FOV: 45 degrees. Color fundus image. 2212 by 1659 pixels:
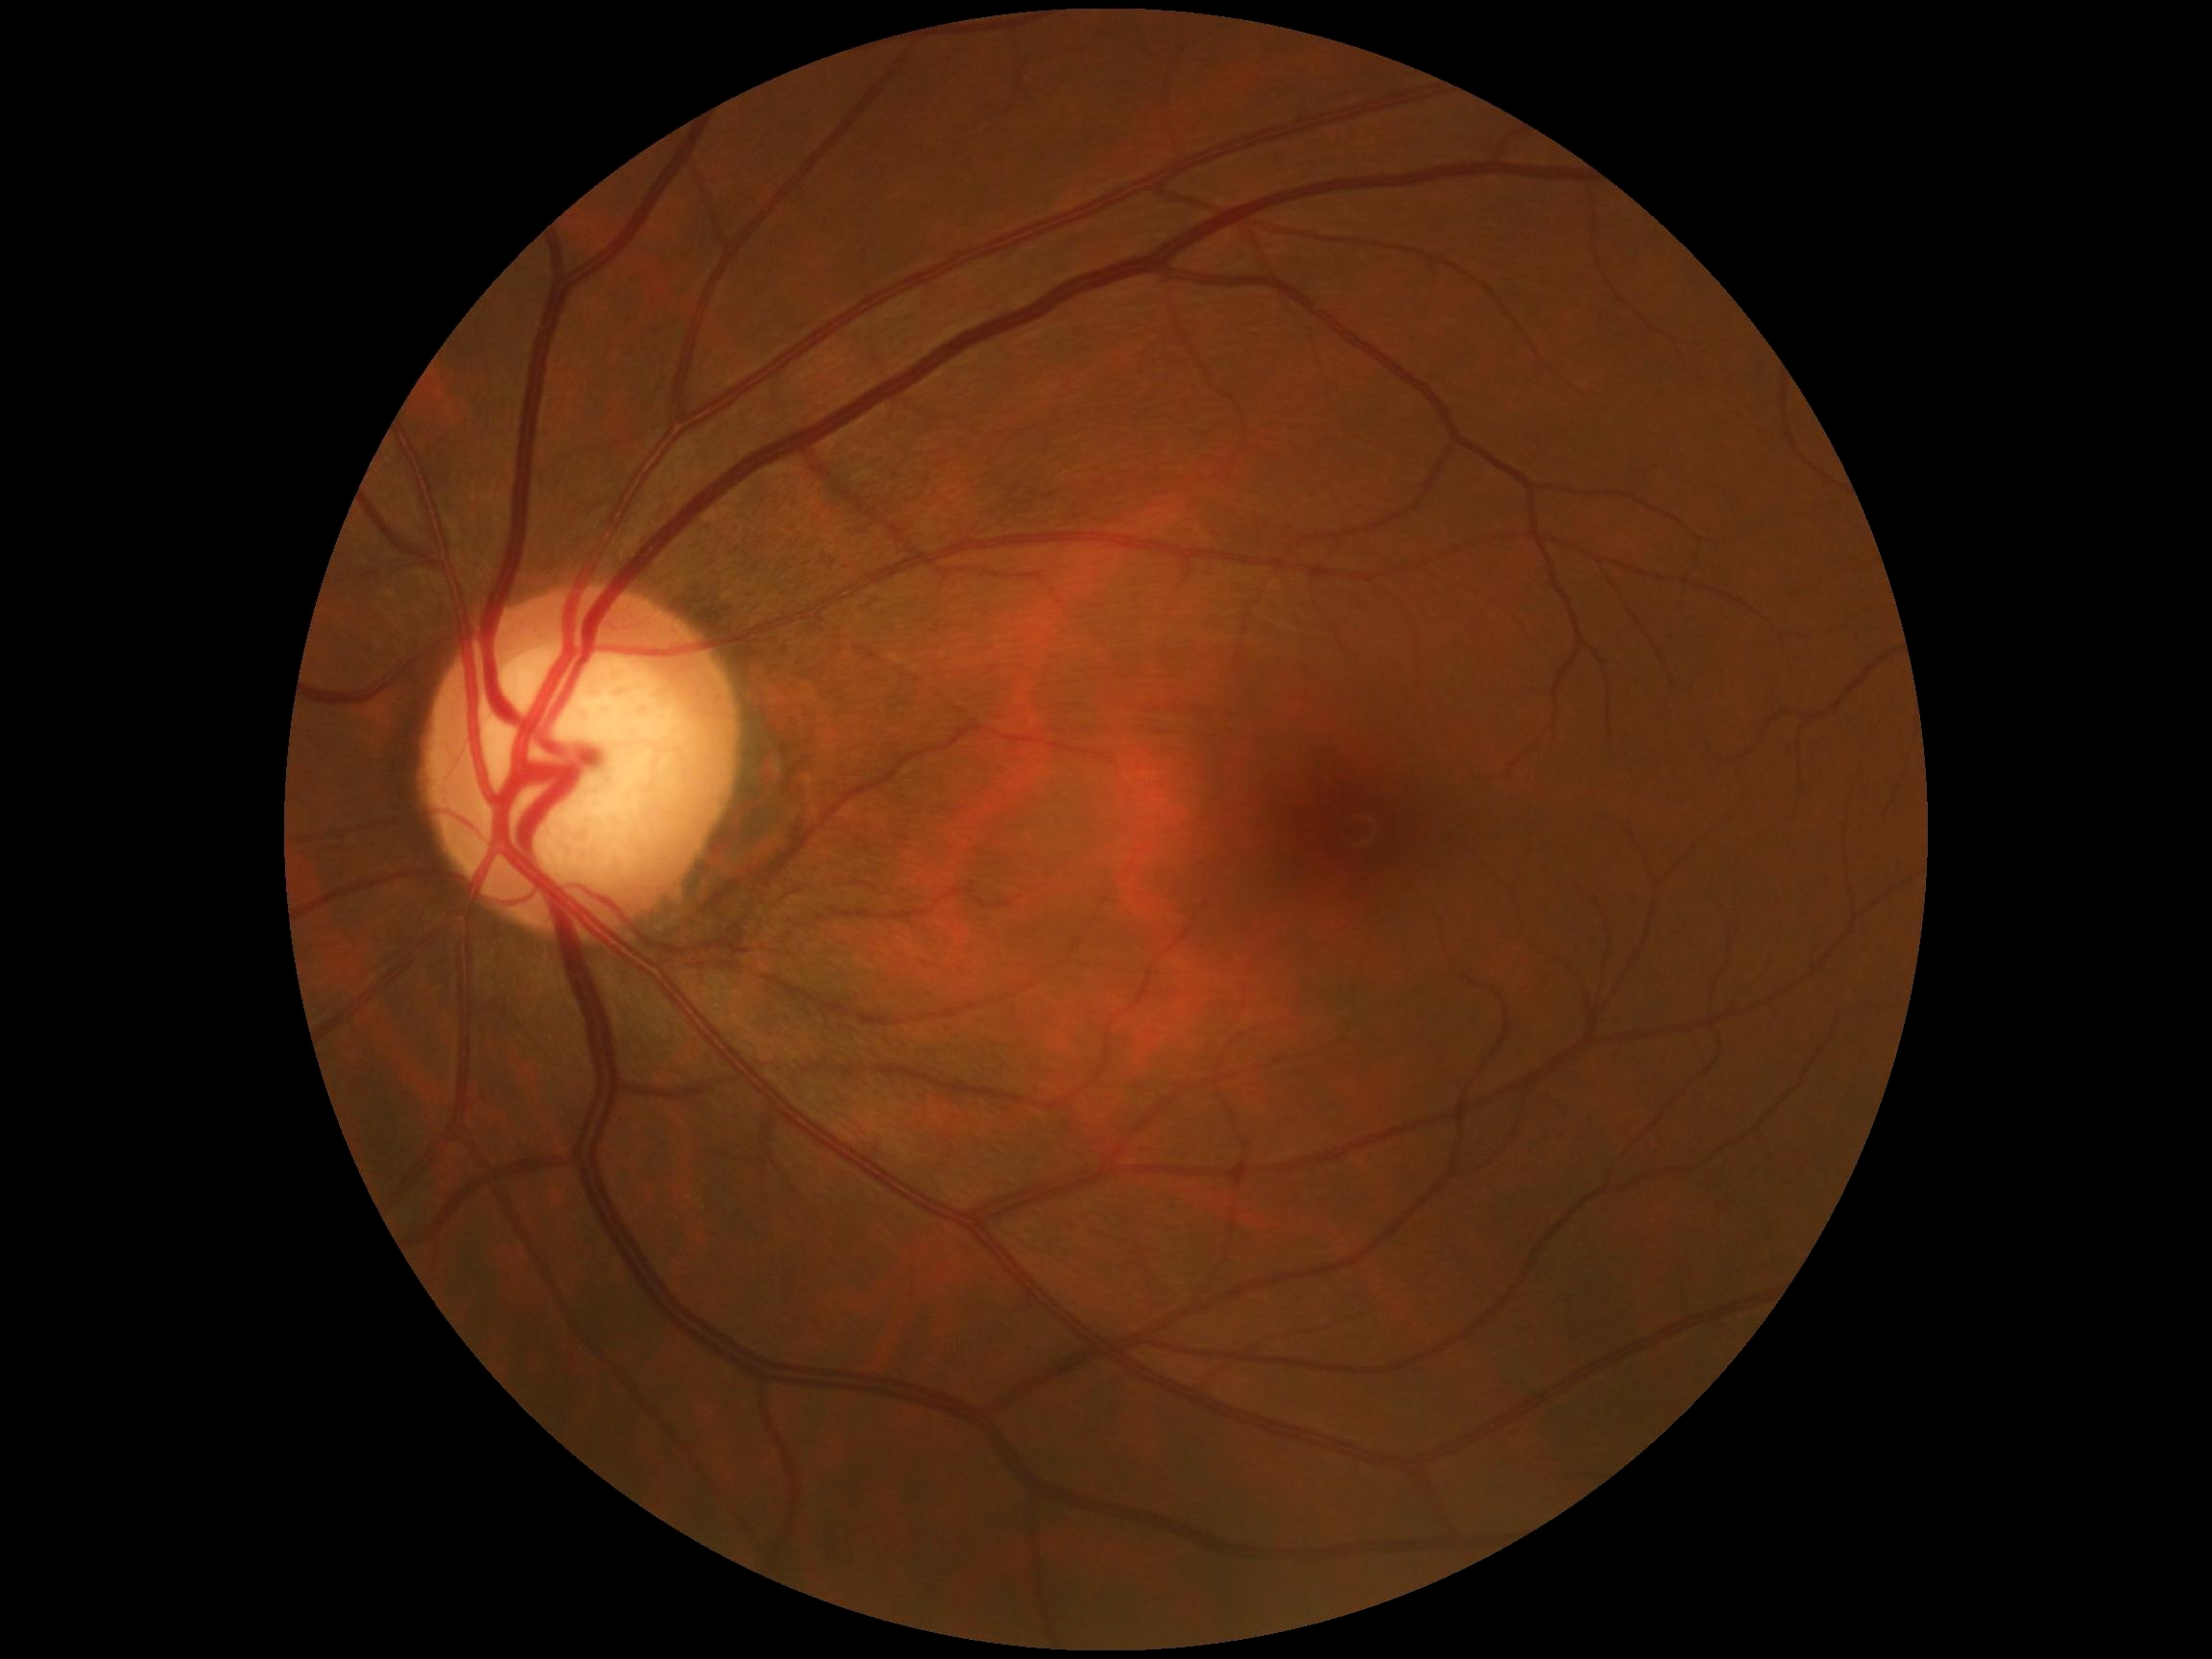

{
  "dr_grade": "no apparent diabetic retinopathy (0) — no visible signs of diabetic retinopathy"
}